Graded on the modified Davis scale, color fundus image, no pharmacologic dilation.
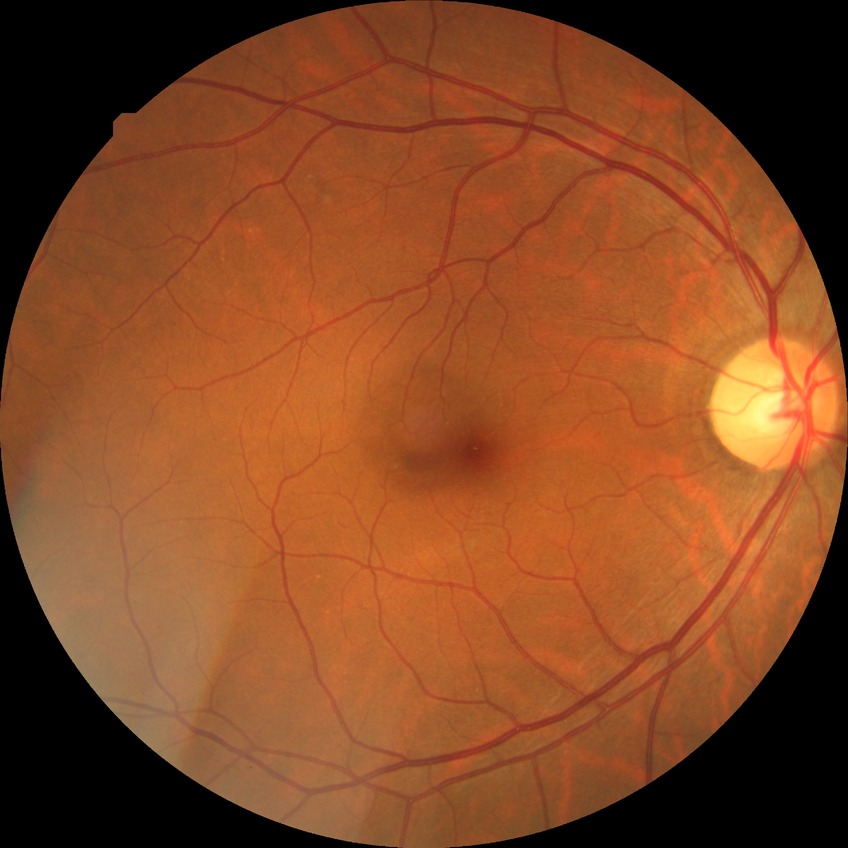

Davis grading: no diabetic retinopathy.